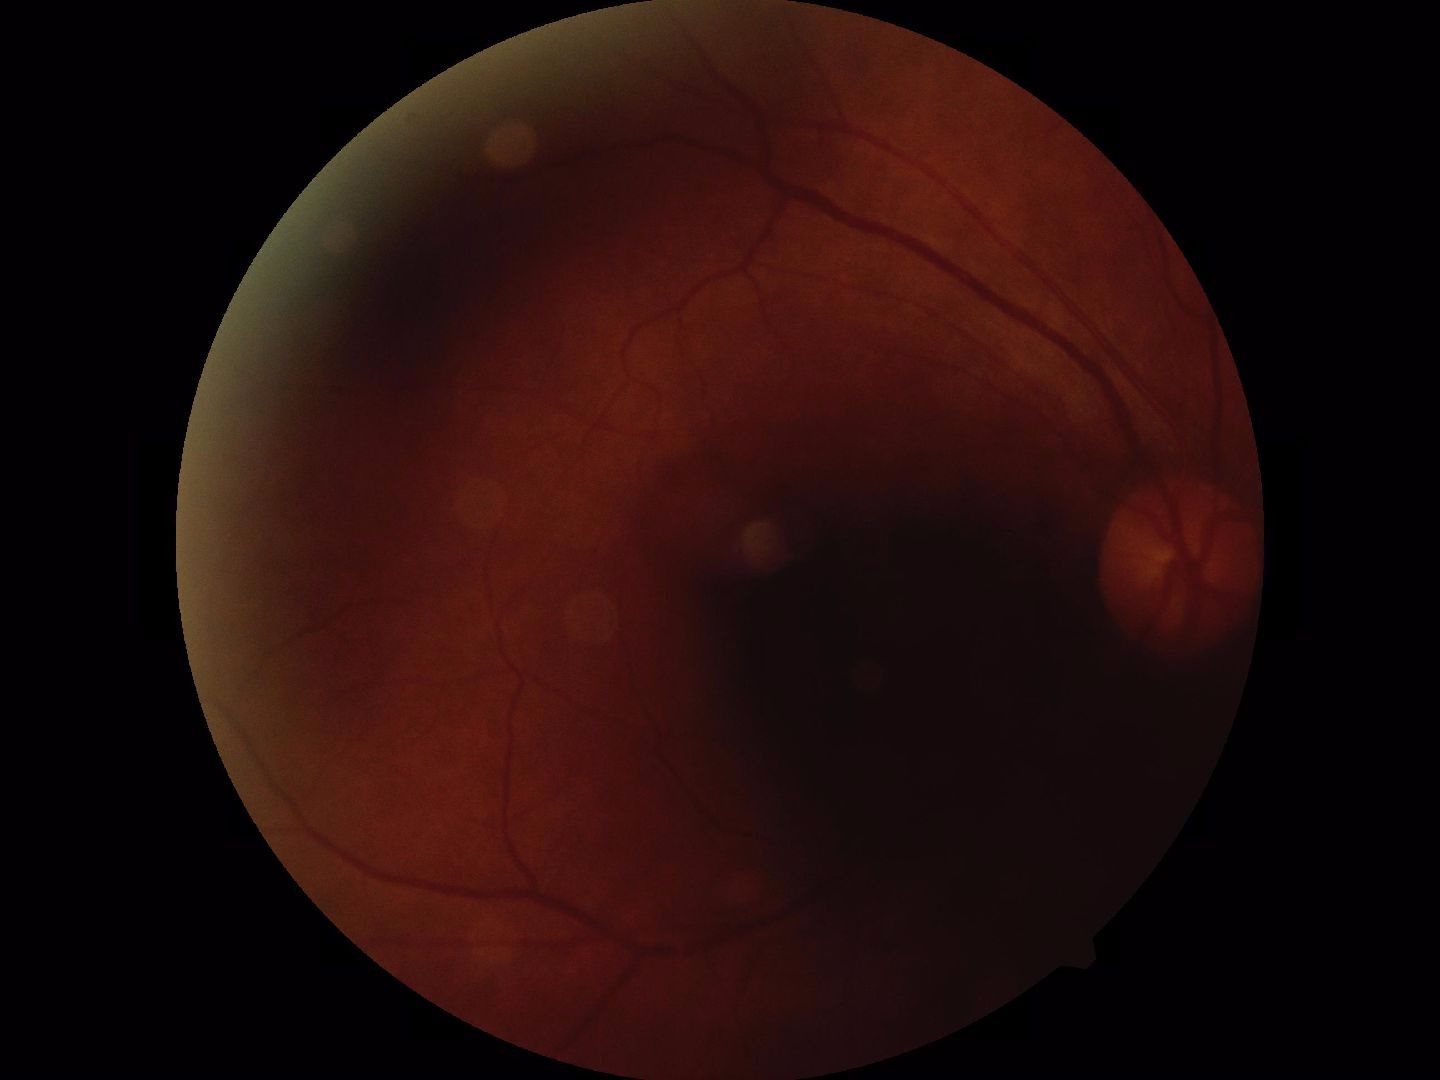 Gradability: blurred, more than half the field obscured. Proliferative retinopathy: negative.